Optic disc region of a color fundus photo.
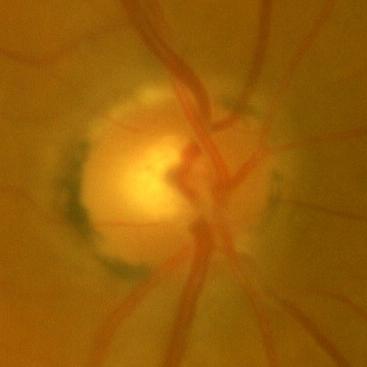

No glaucomatous findings.